45° field of view; NIDEK AFC-230 fundus camera; 848 by 848 pixels; Davis DR grading; without pupil dilation: 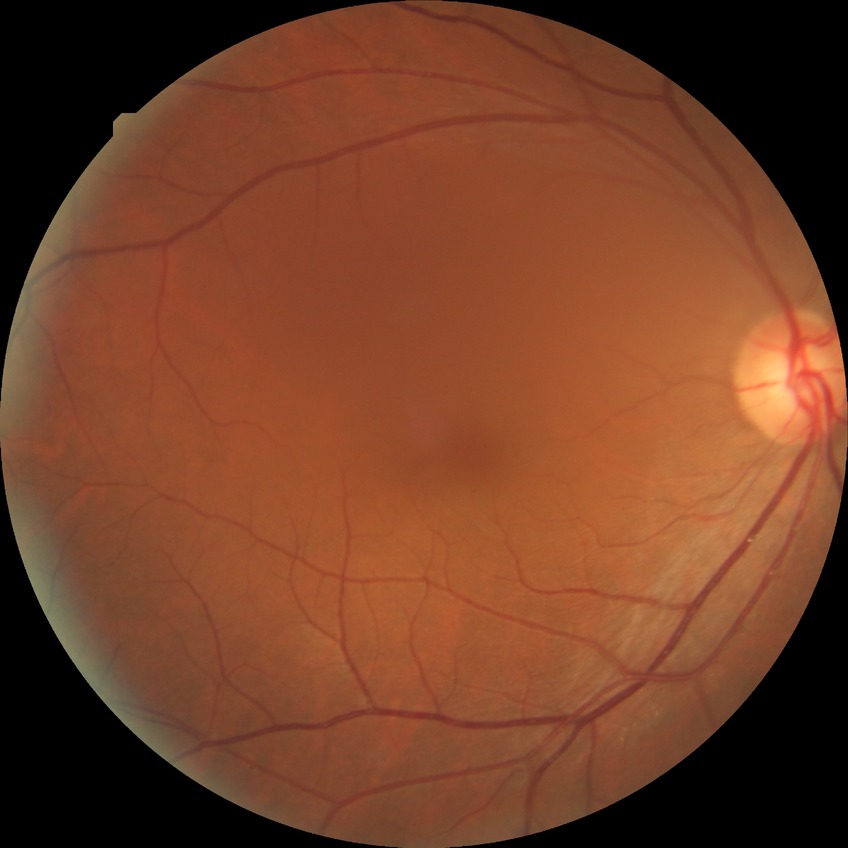 Diabetic retinopathy grade: no diabetic retinopathy.